1932 x 1932 pixels. 50° FOV. Color fundus photograph.
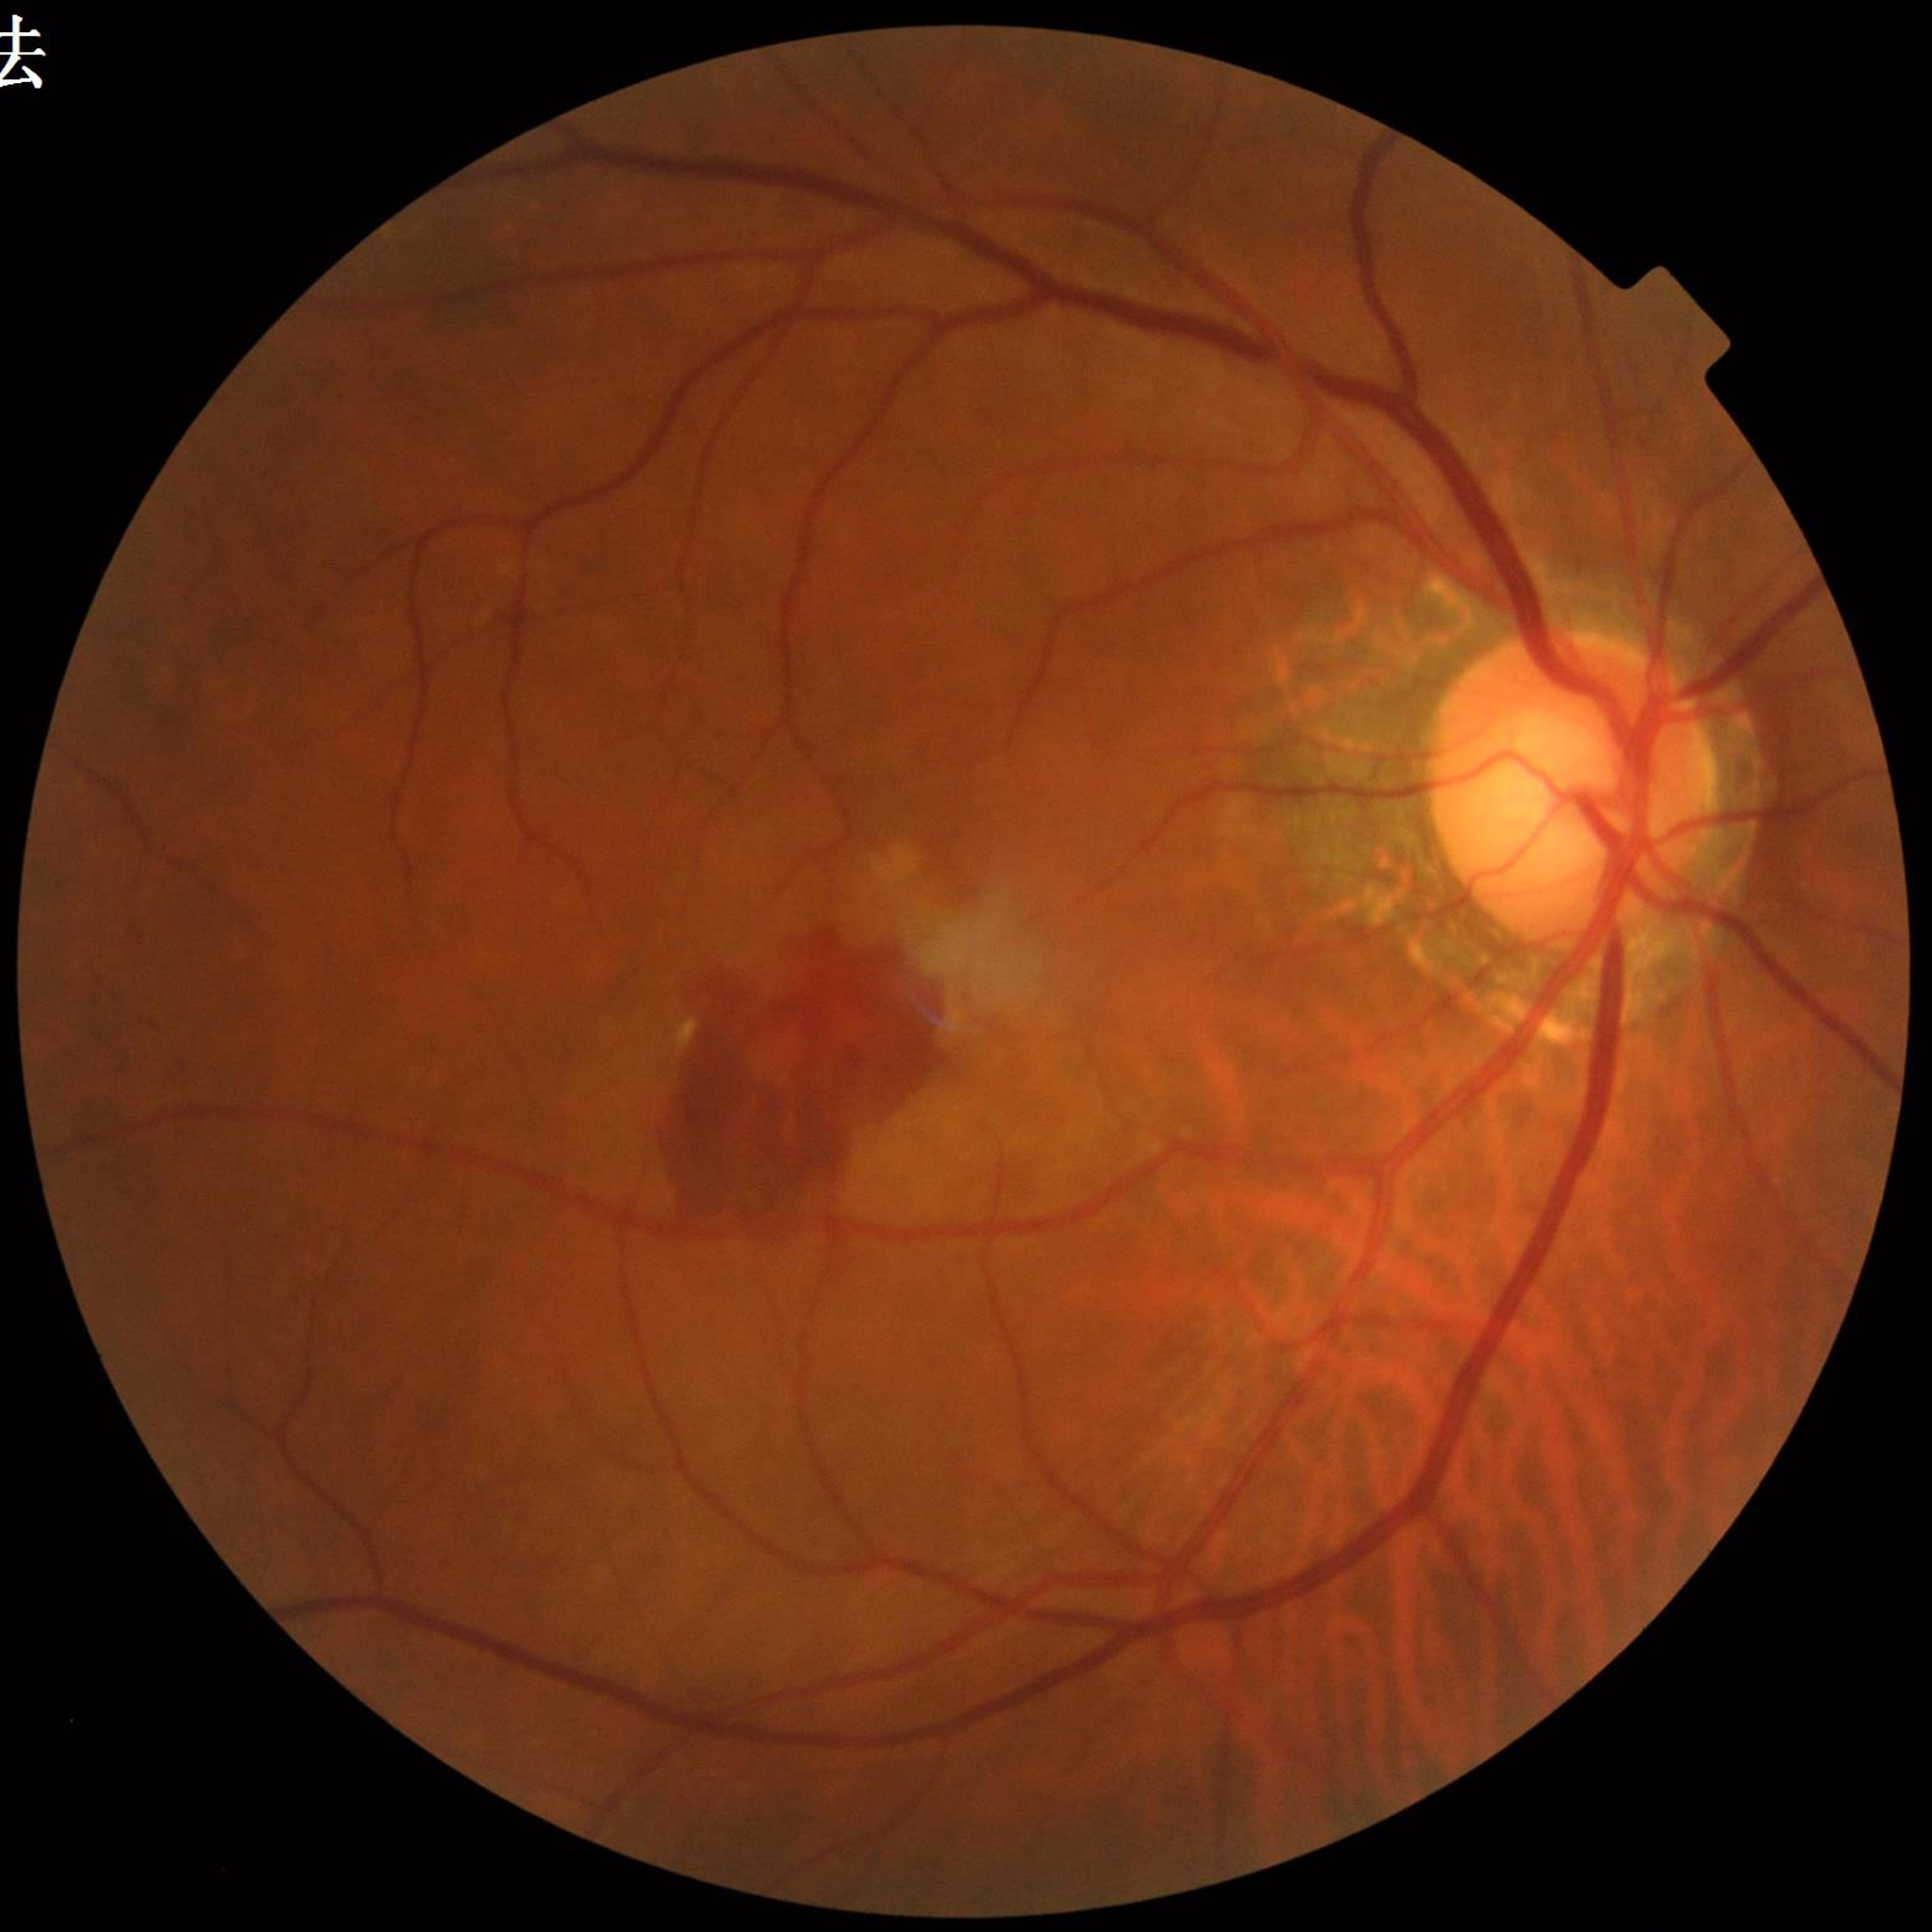 From a patient with AMD.
Photo quality: no concerns identified.